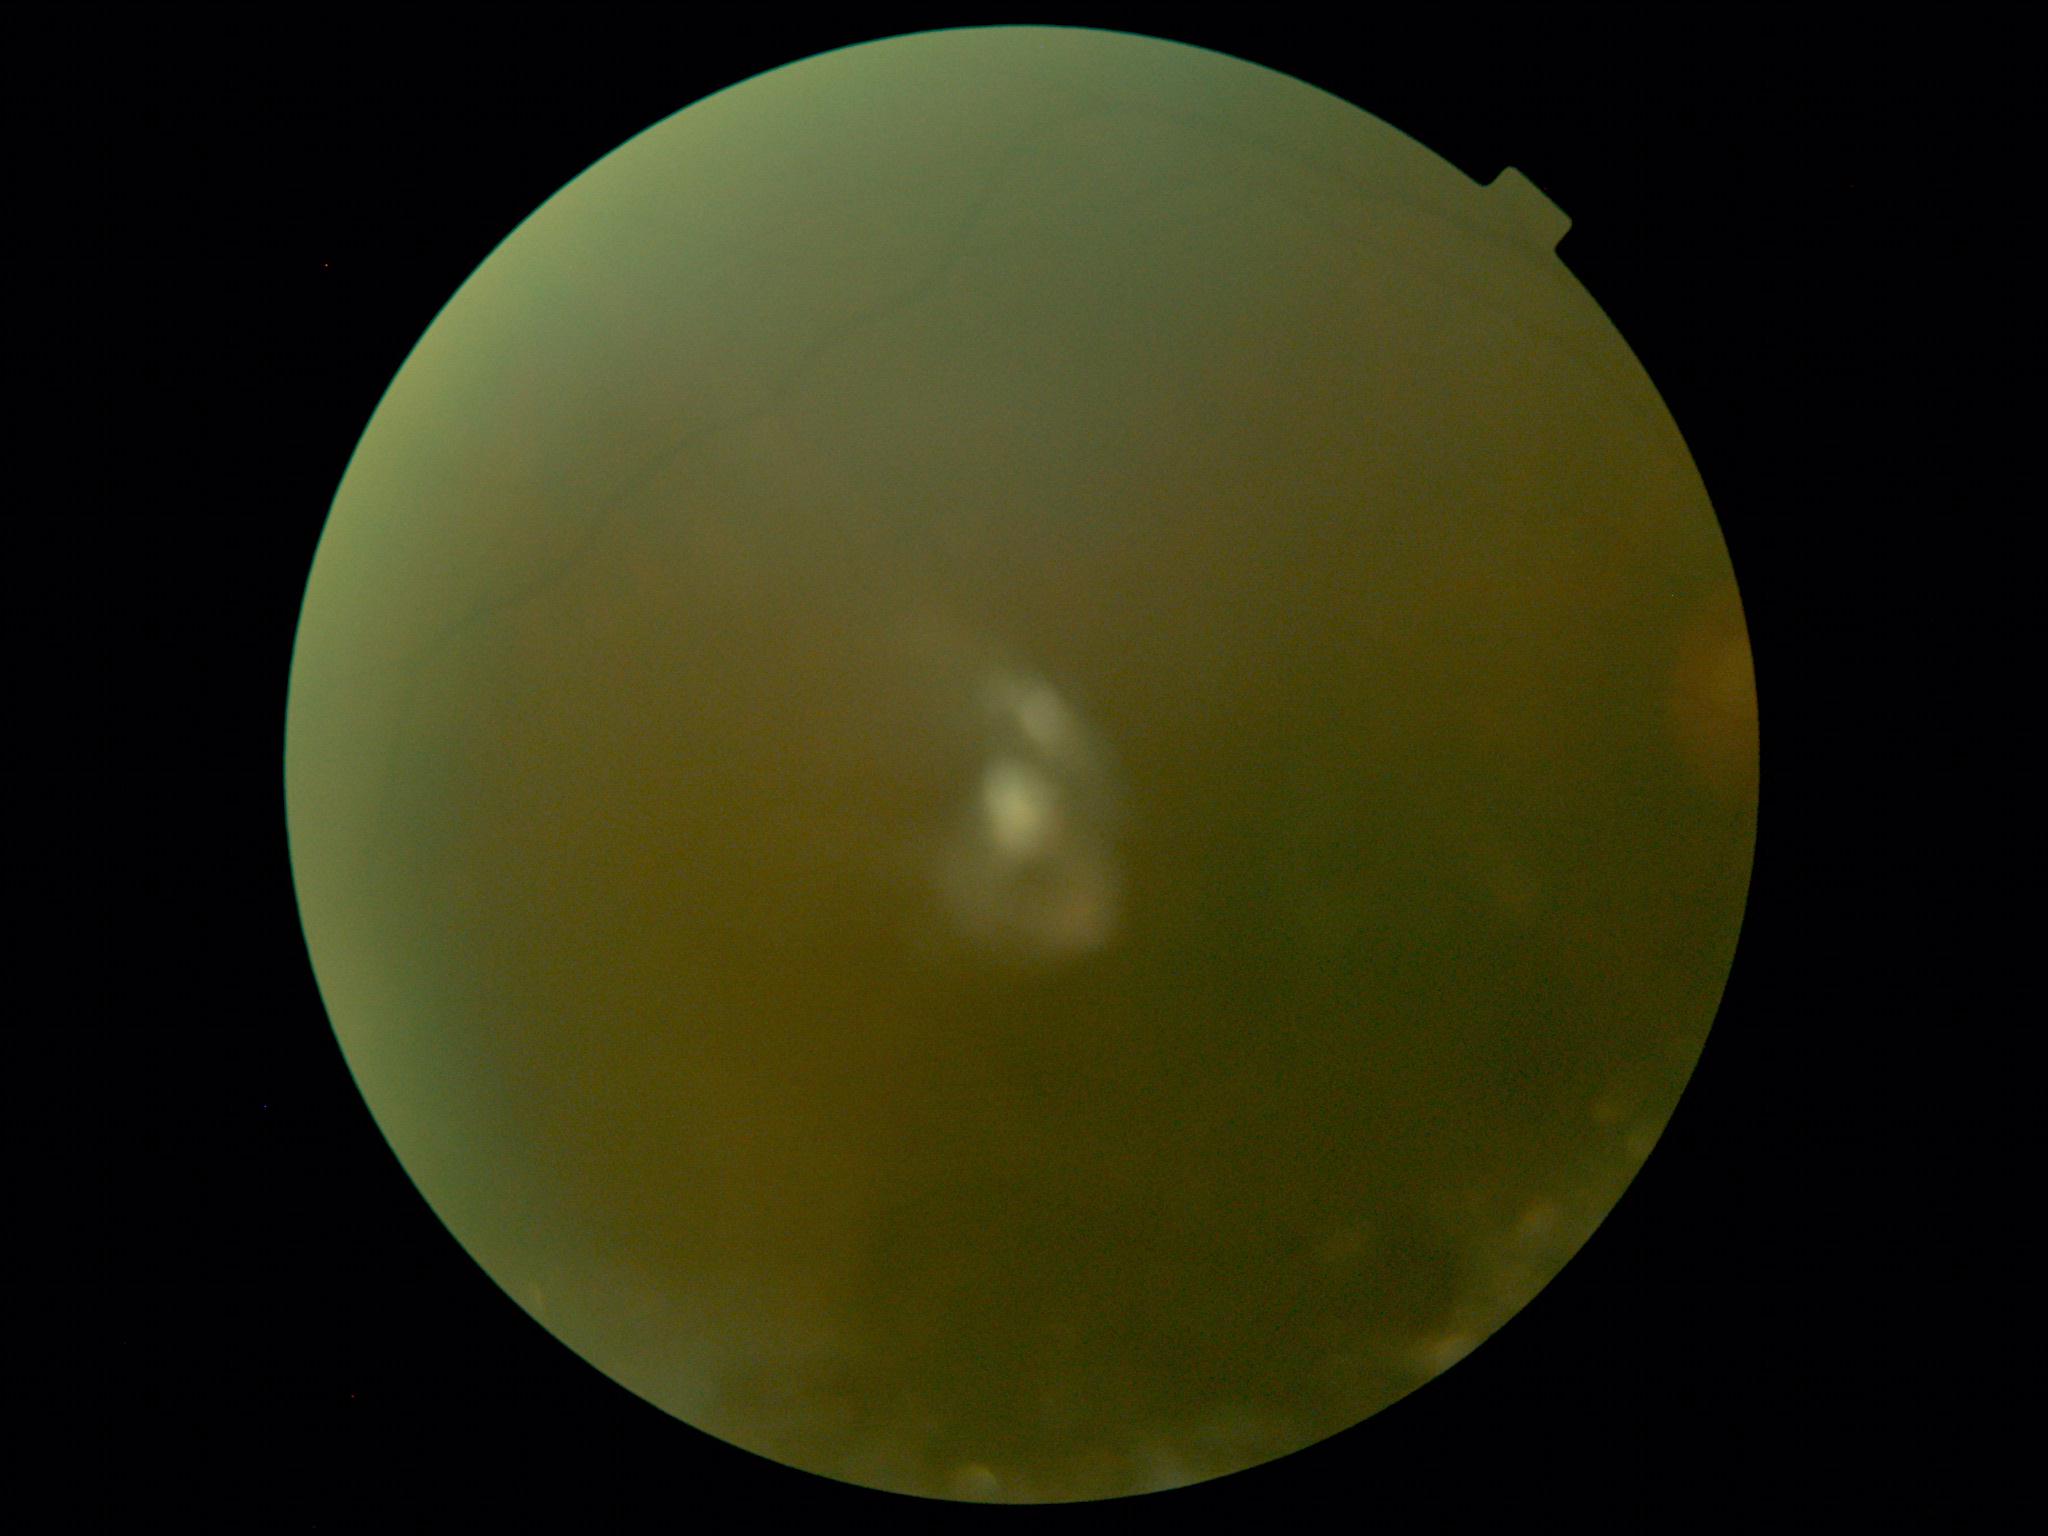

Retinopathy: ungradable due to poor image quality.